2212 x 1659 pixels · CFP — 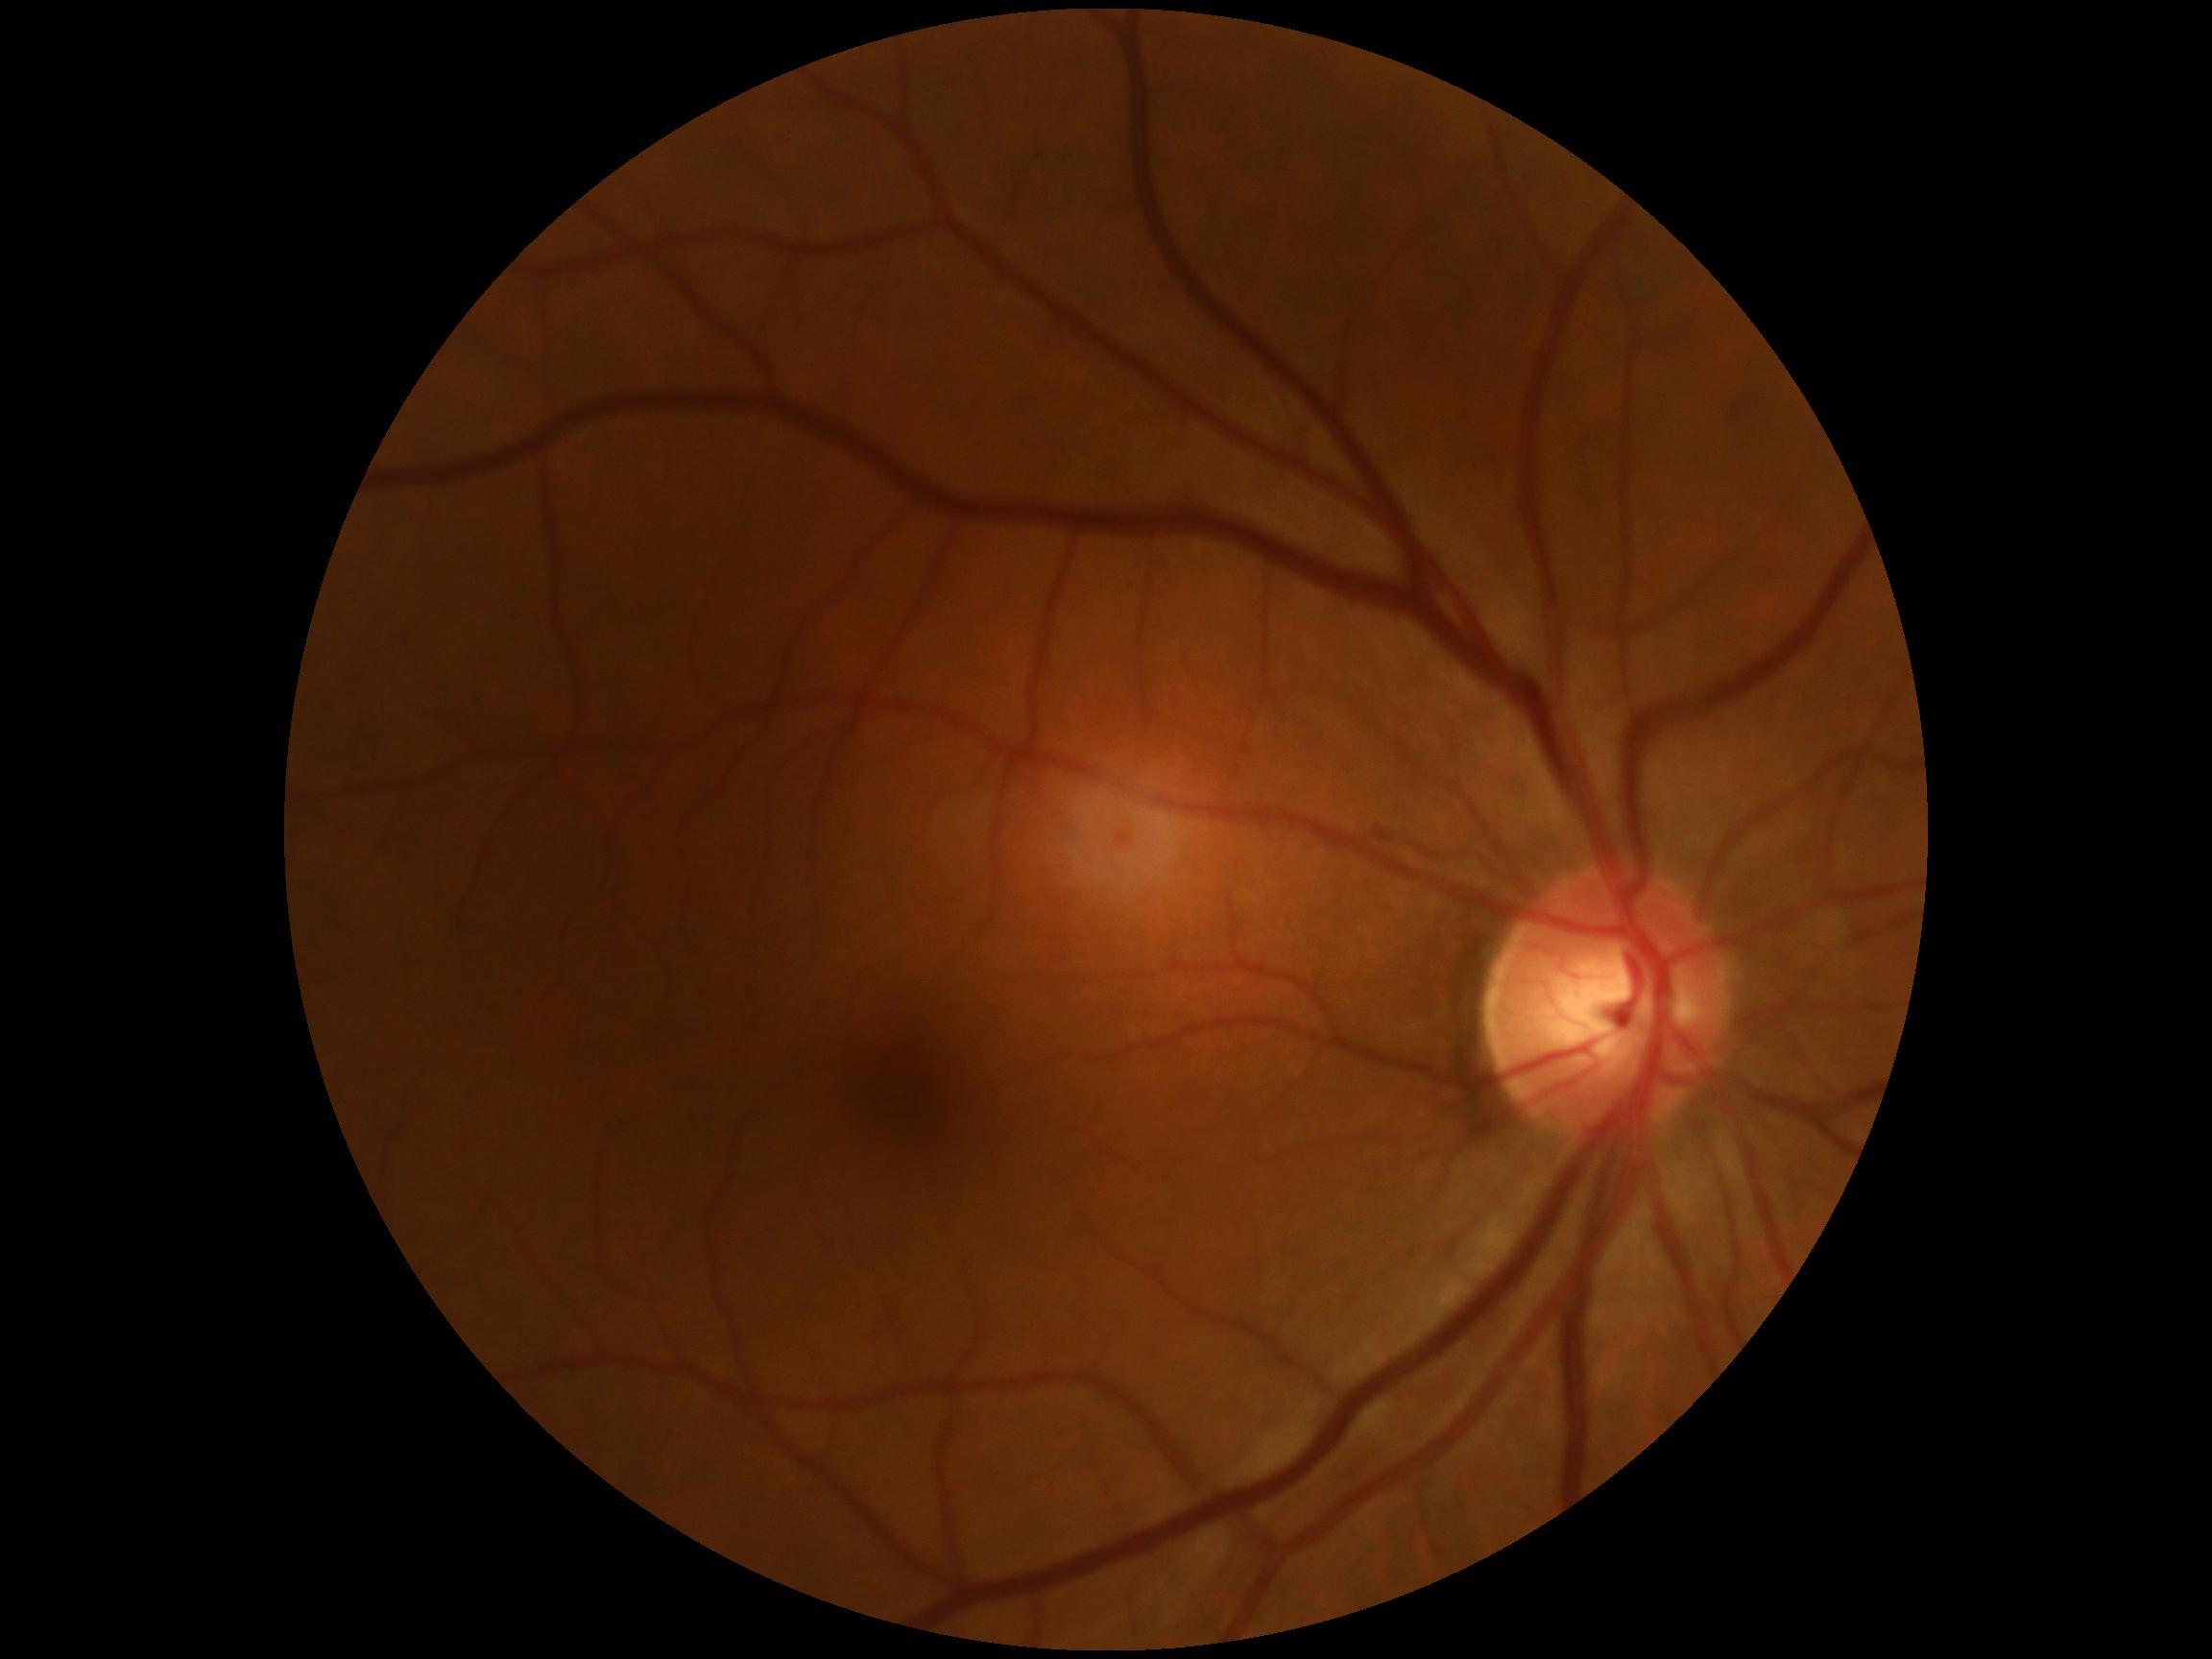 Findings:
– DR stage — no apparent diabetic retinopathy (grade 0)